1659x2212px: 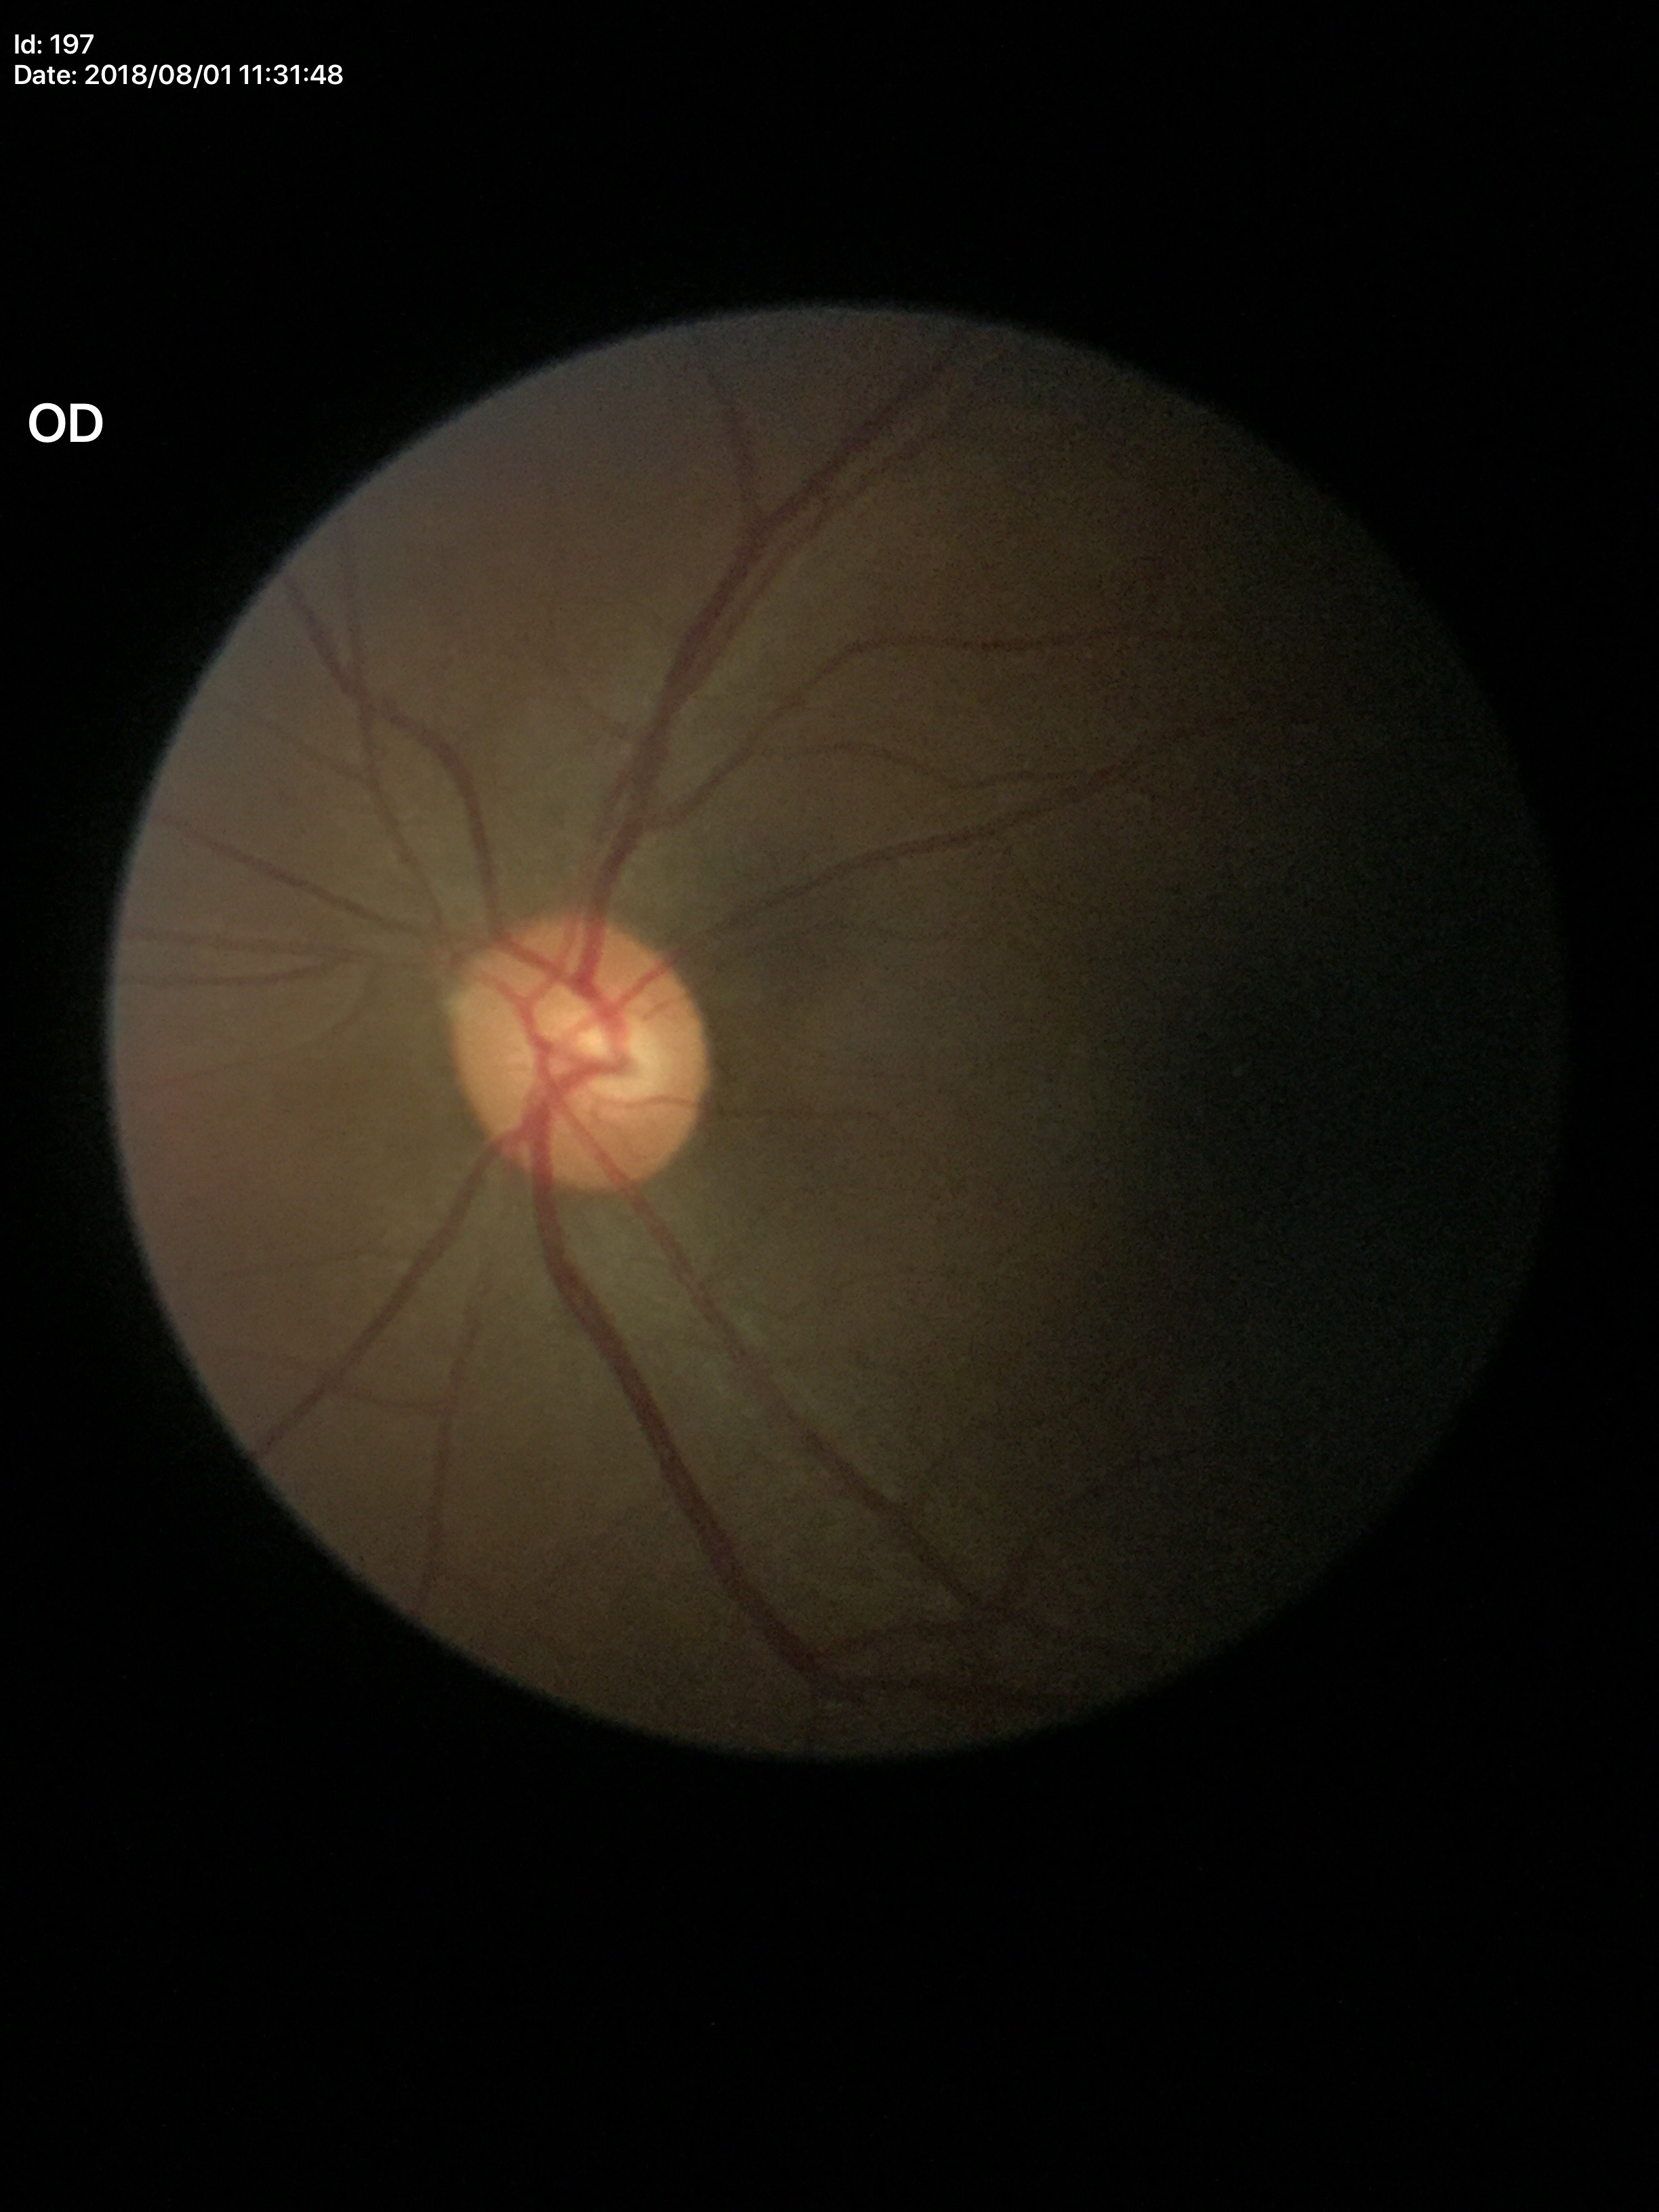
vertical CDR = 0.49, area CDR = 0.27, Glaucoma evaluation = negative.